45° FOV. No pharmacologic dilation:
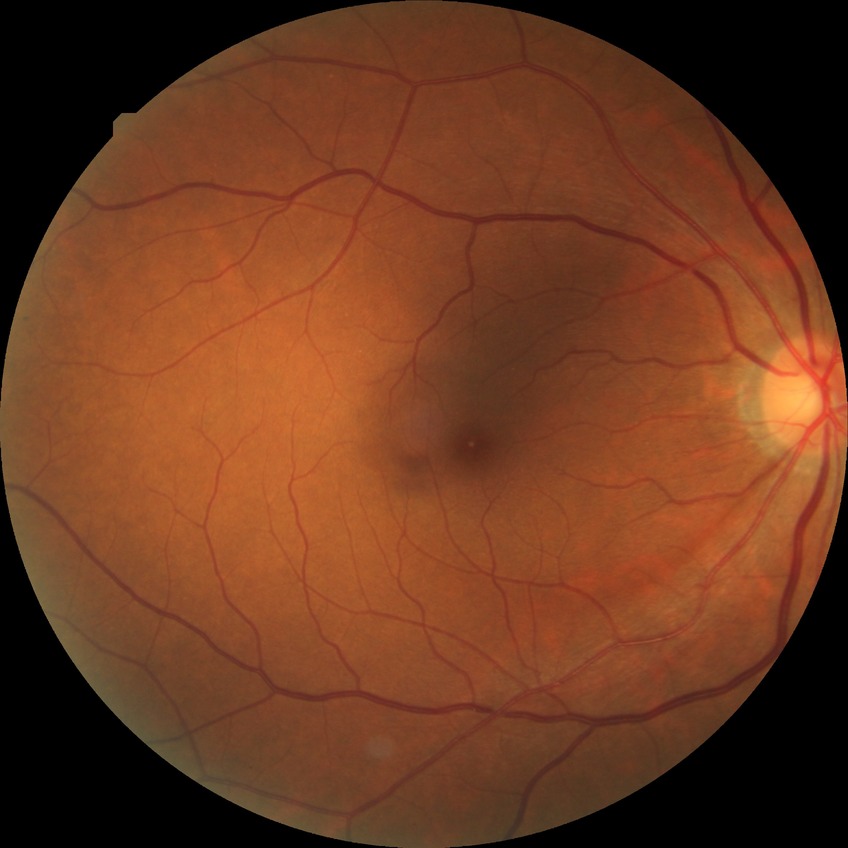
retinopathy grade = no diabetic retinopathy.